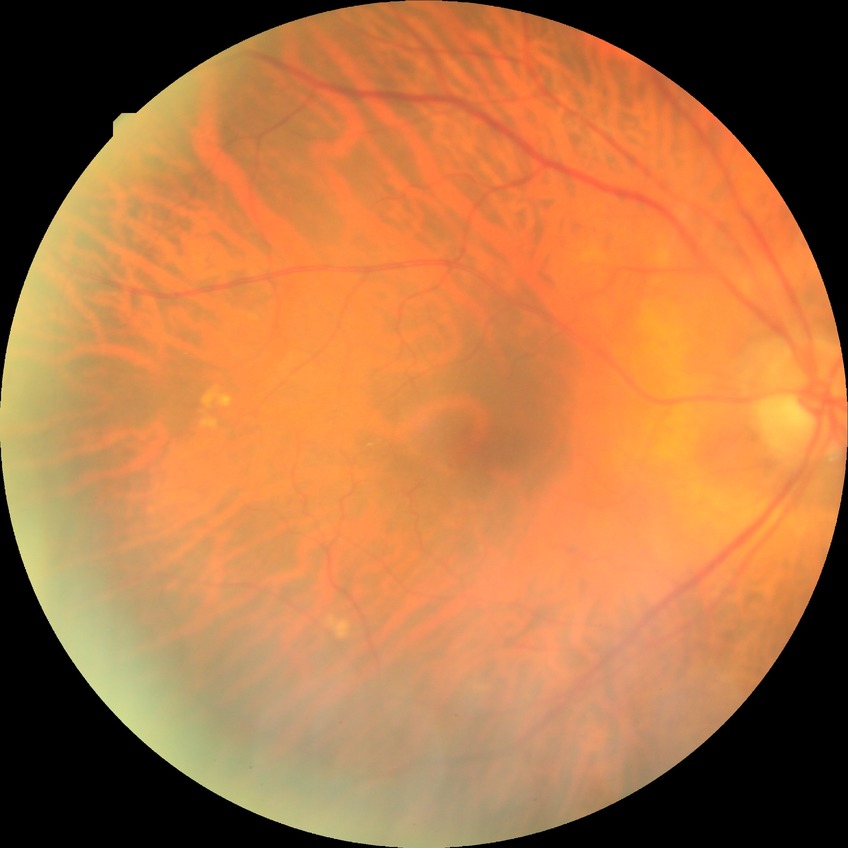

DR stage is NDR.